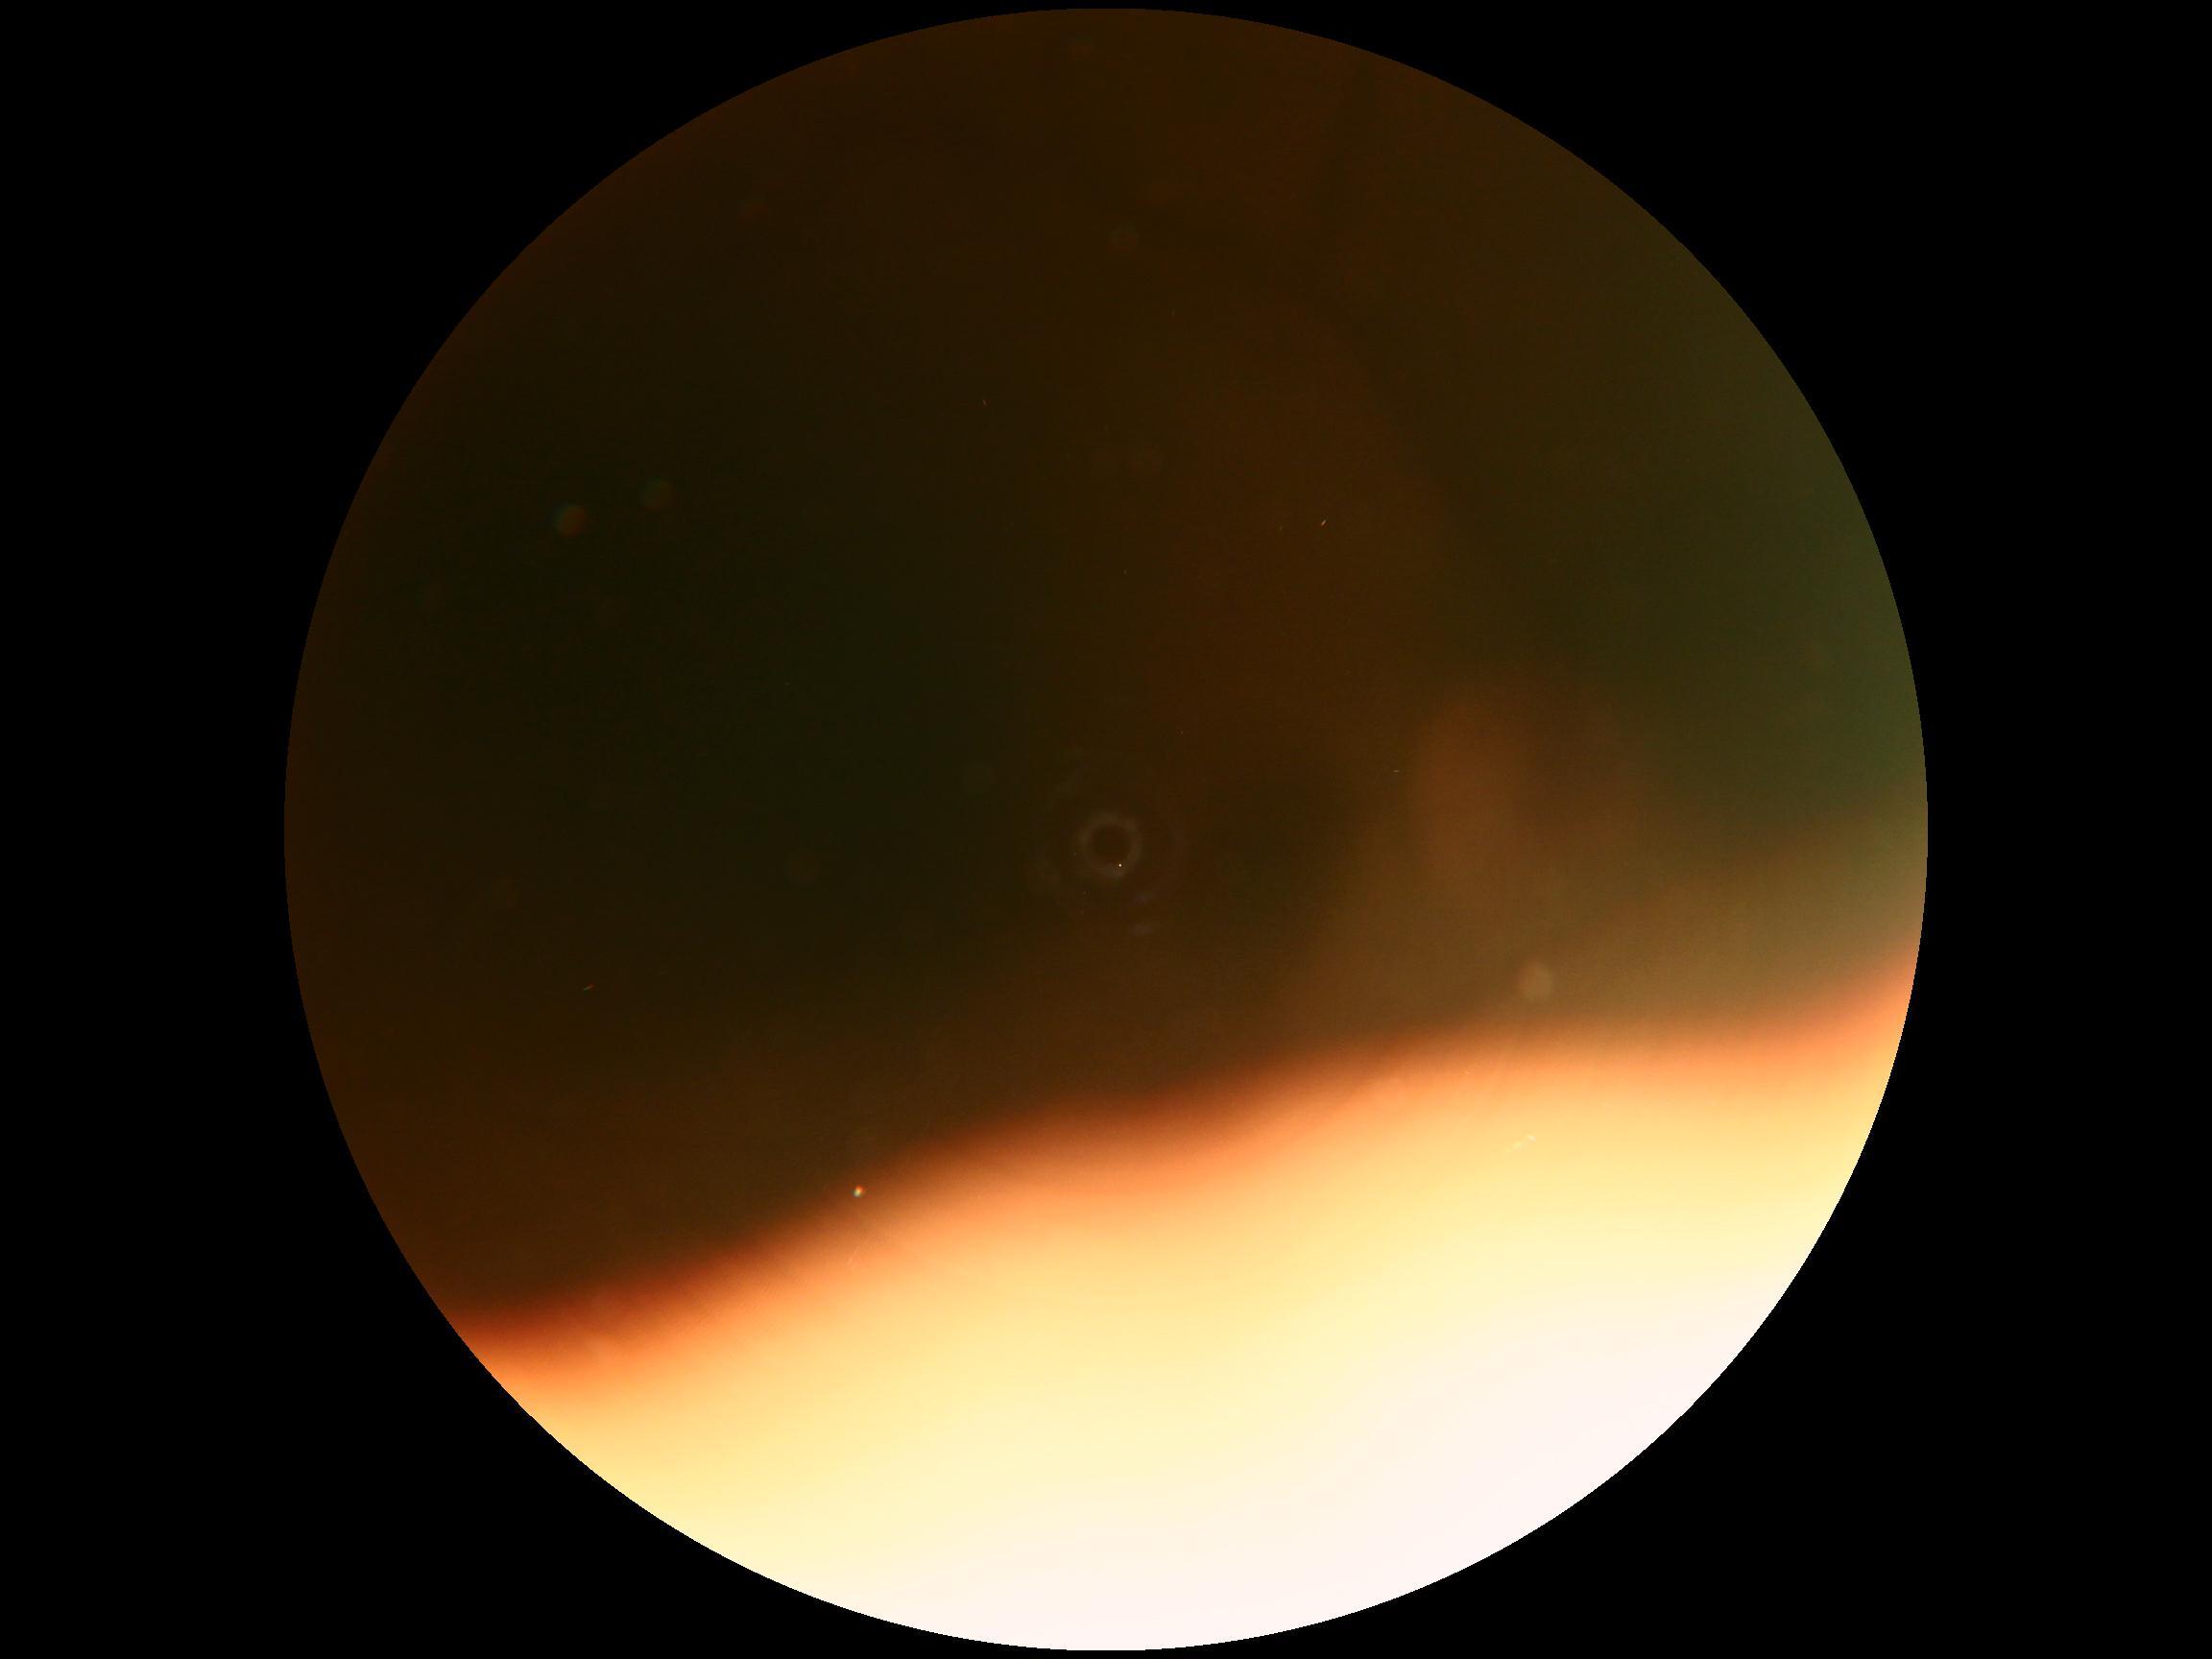
image quality=insufficient for DR assessment, DR stage=ungradable due to poor image quality.